1504 by 1000 pixels; CFP: 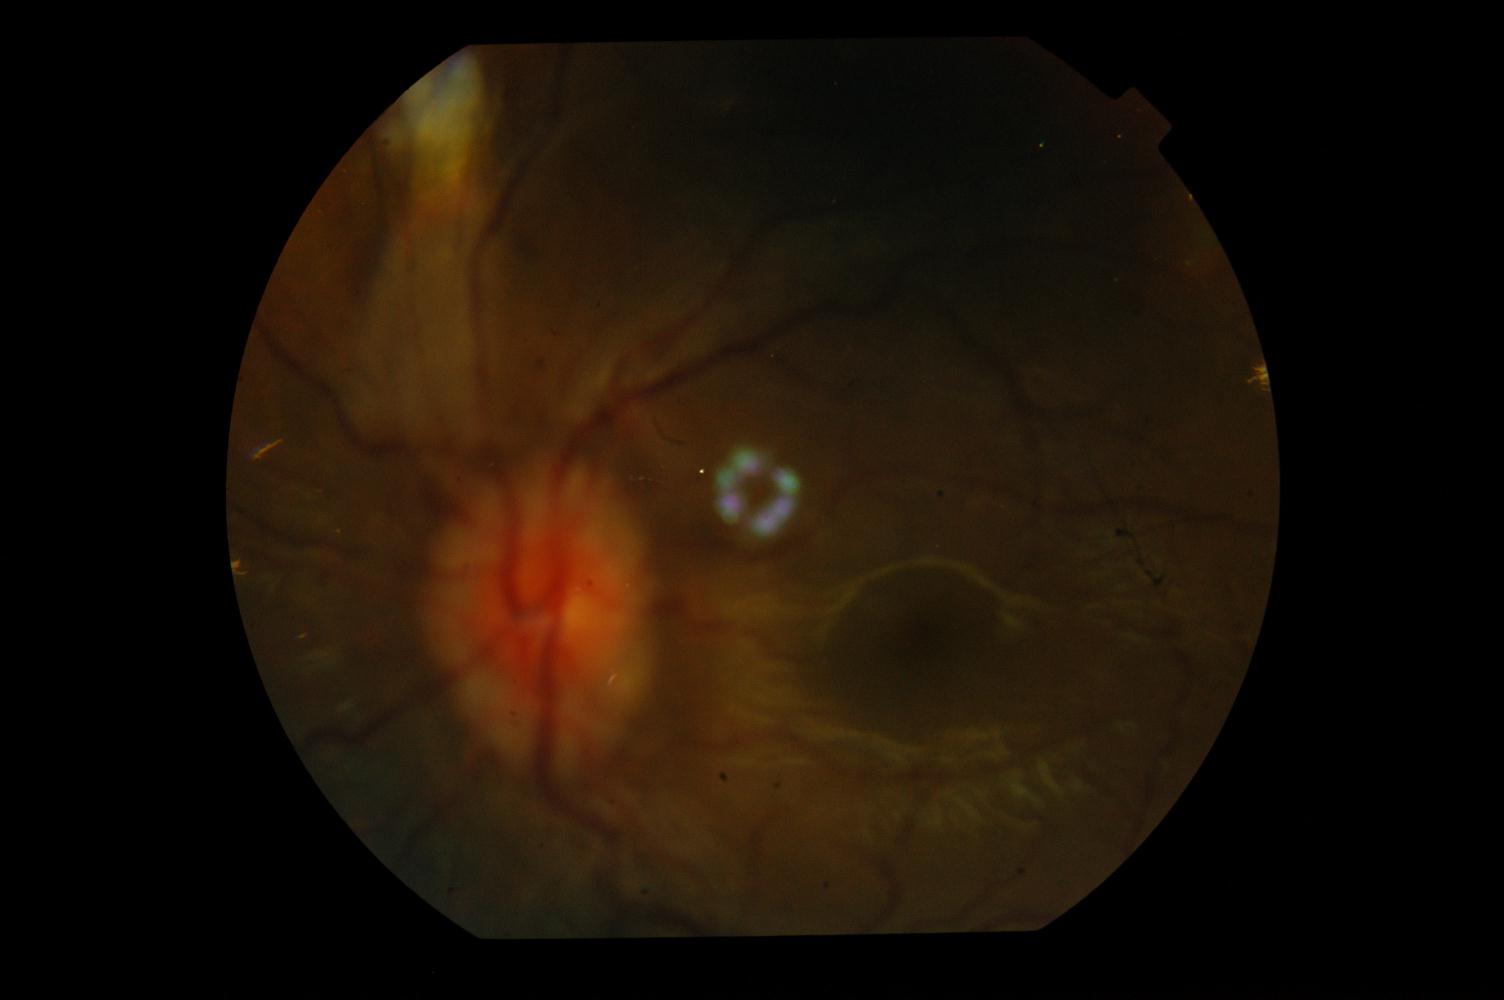
Diagnosis:
- idiopathic intracranial hypertension